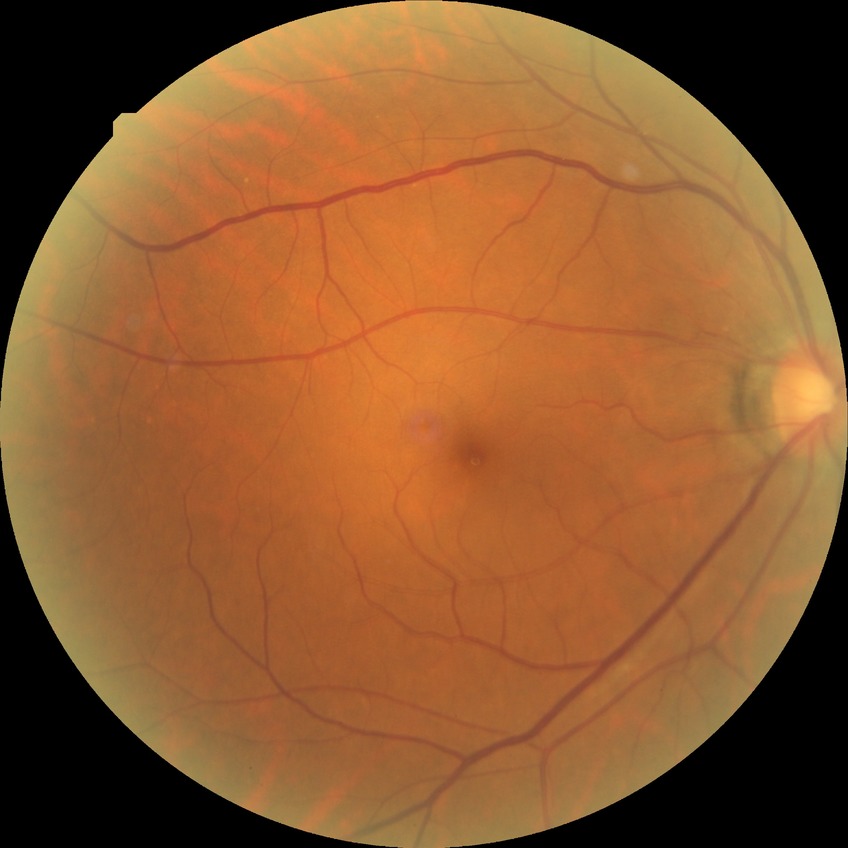 Retinopathy grade is no diabetic retinopathy.